45° FOV: 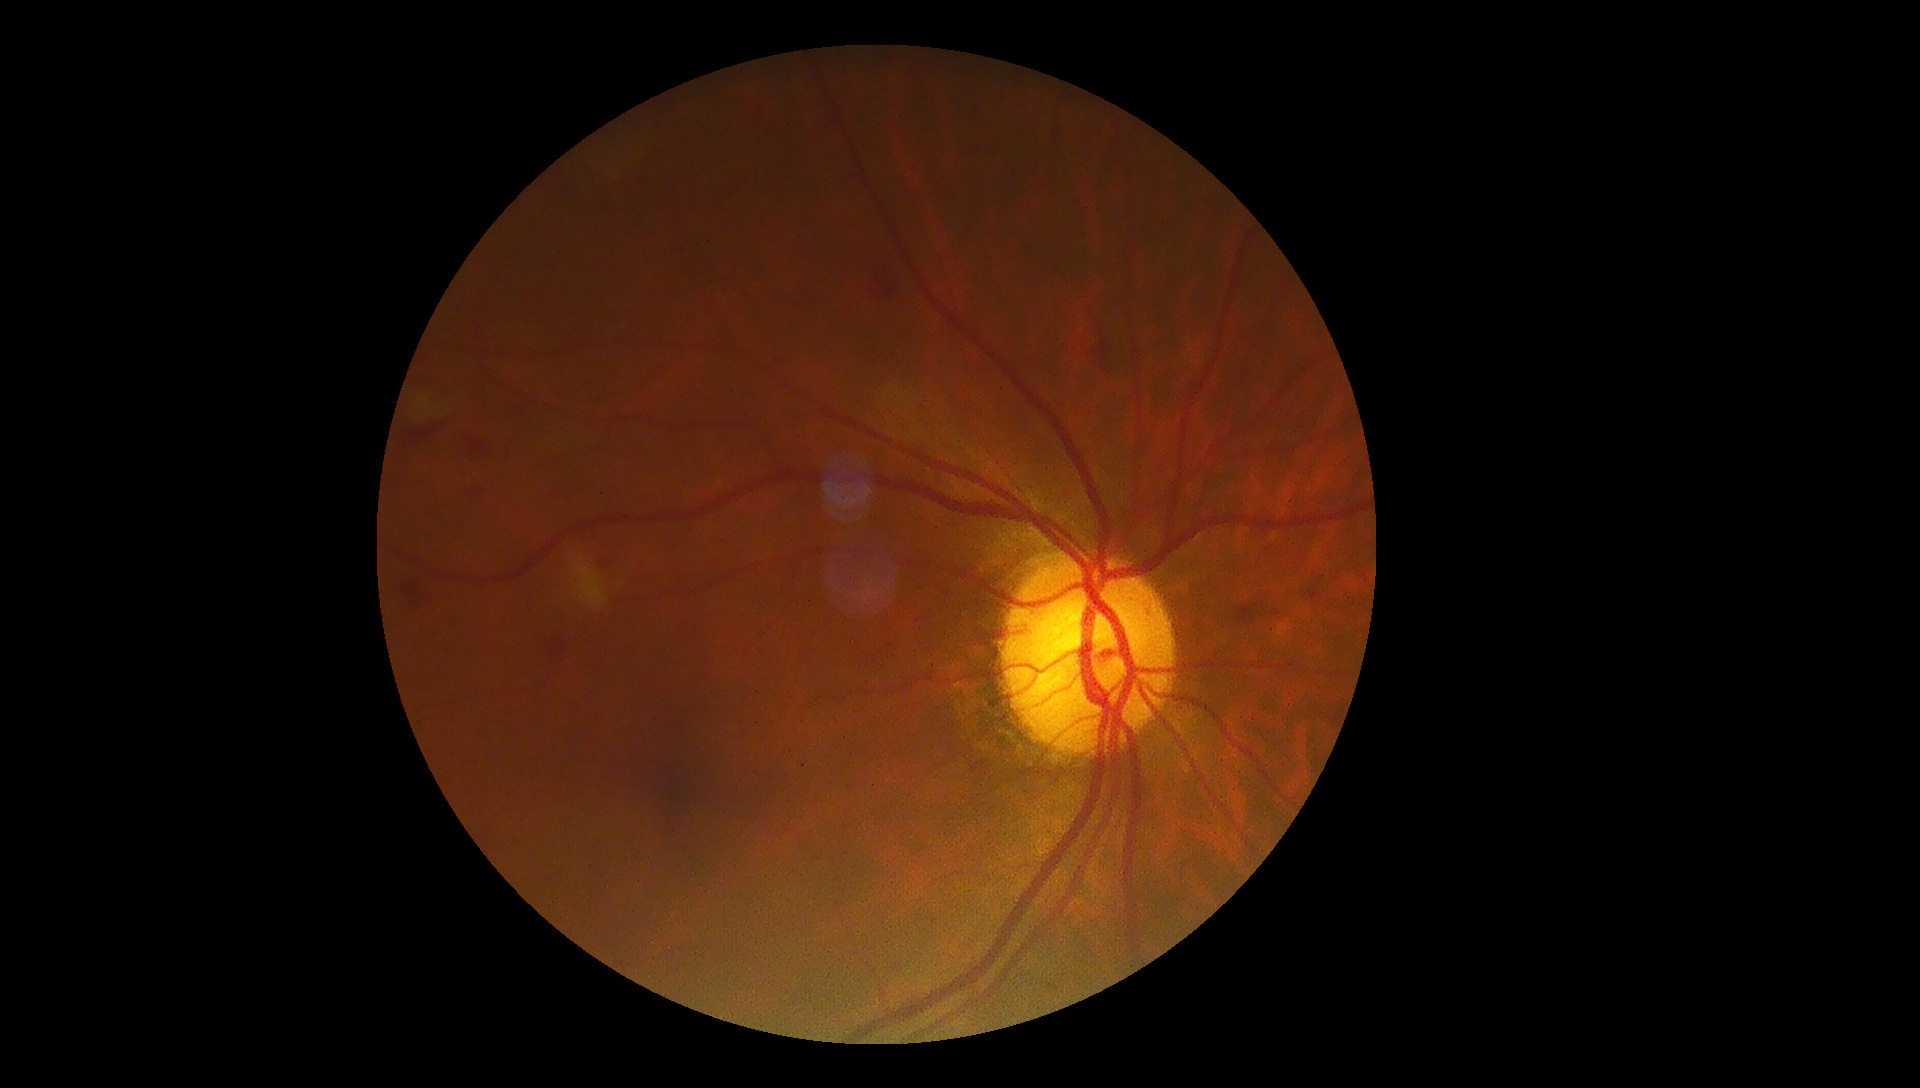 Annotations:
• DR: 2